Topcon TRC-50DX, dilated-pupil acquisition, central posterior field, color fundus image, 2228 x 1652 pixels, FOV: 50 degrees:
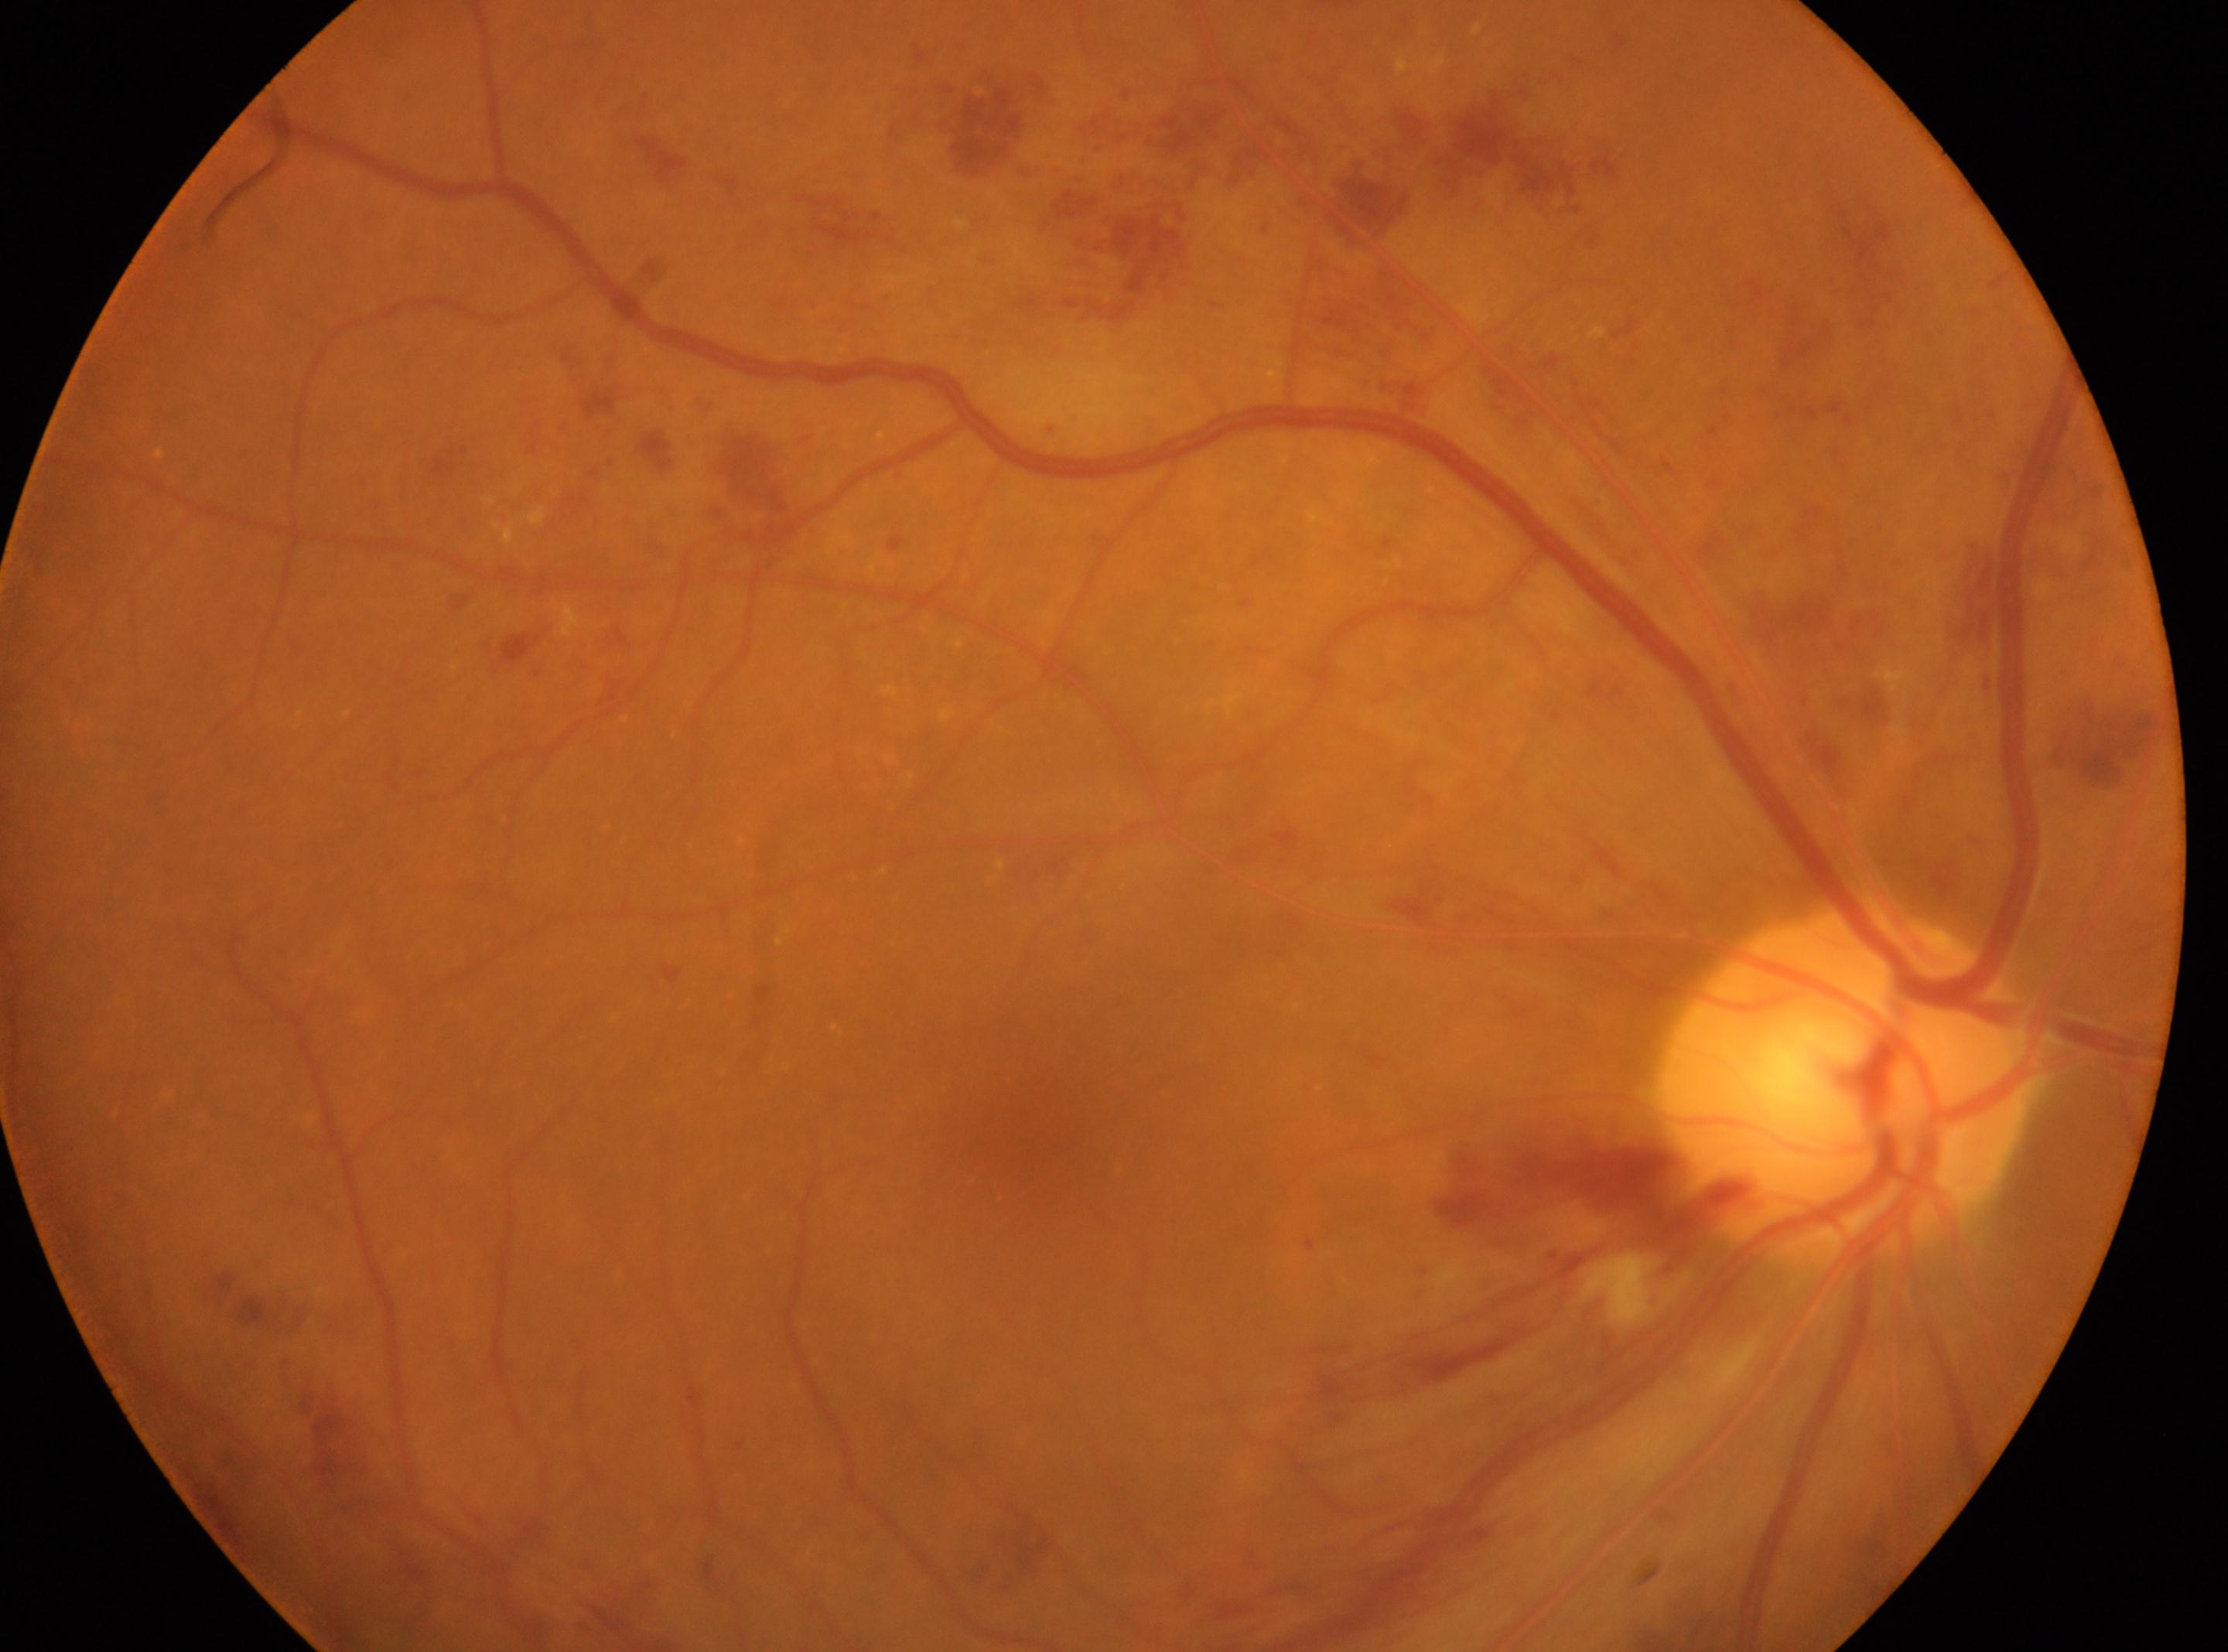 Macular center: (1034,1128).
The disc center is at (1844,1081).
Imaged eye: right.
DR stage: grade 3.